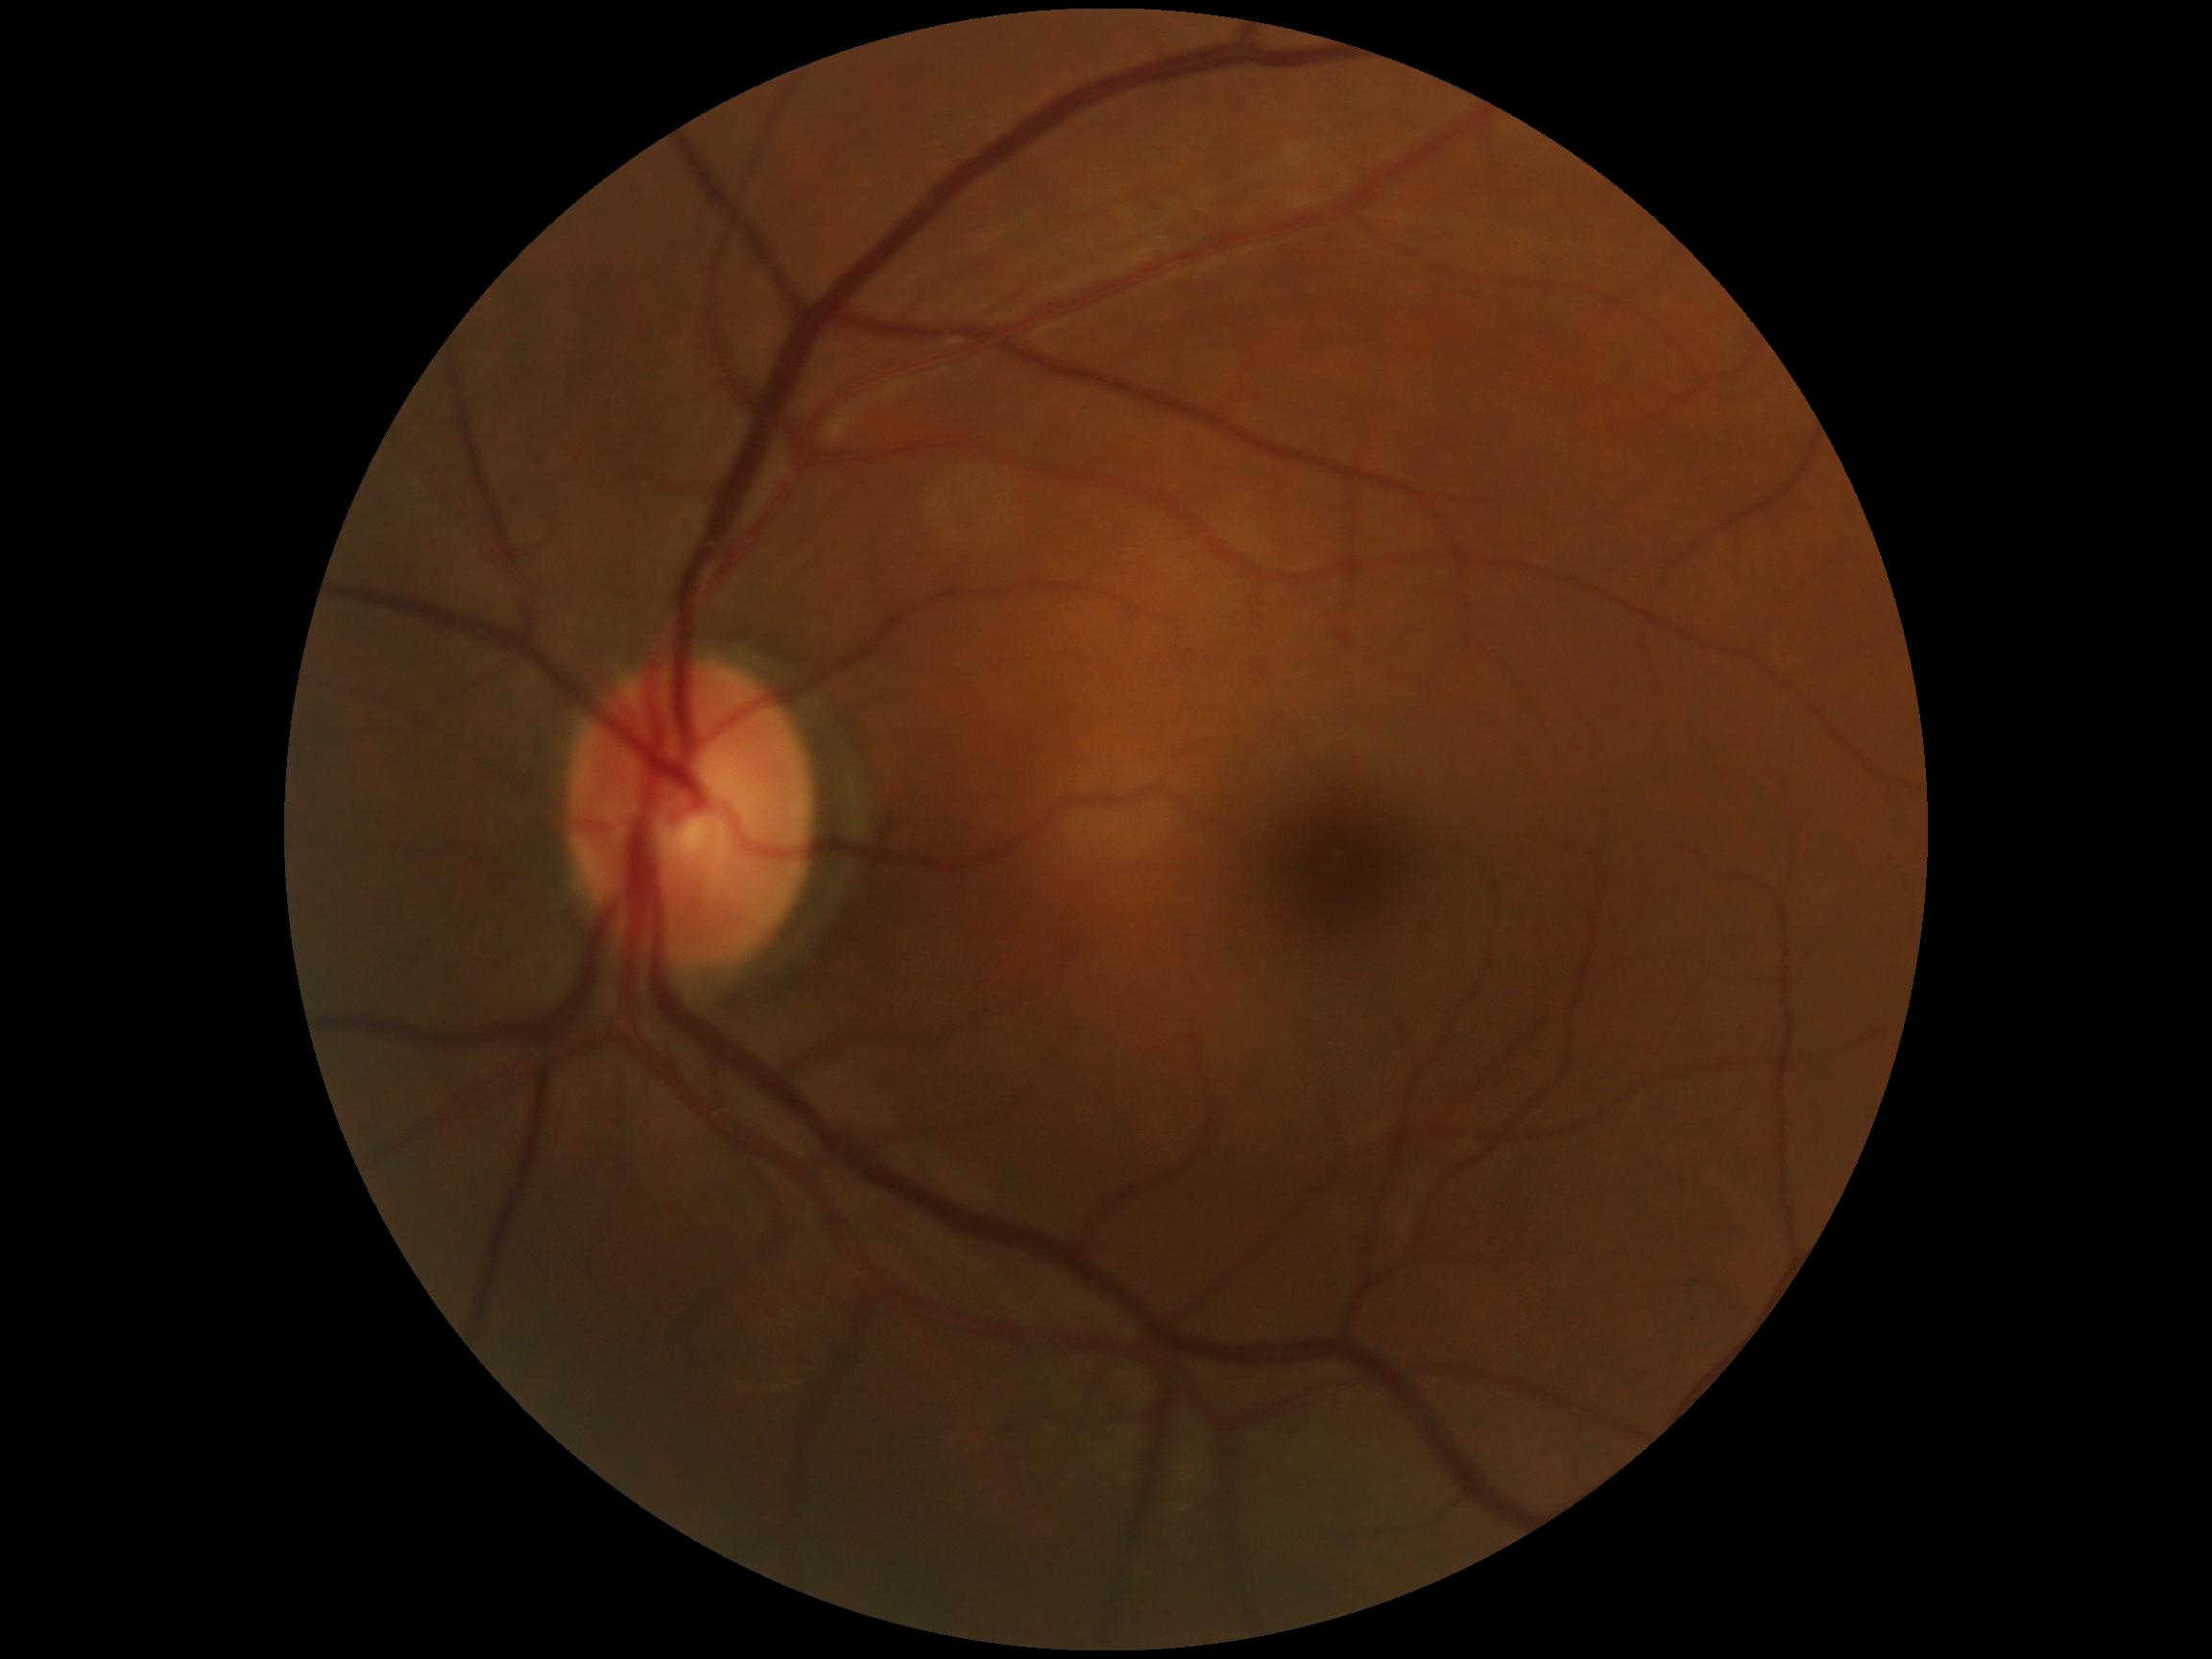 DR severity: grade 0 (no apparent retinopathy).